Camera: Nidek AFC-330. 240 x 240 pixels
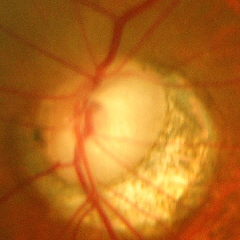
This fundus photograph shows advanced glaucoma.